Color fundus image · 45 degree fundus photograph · NIDEK AFC-230 · nonmydriatic · 848x848px — 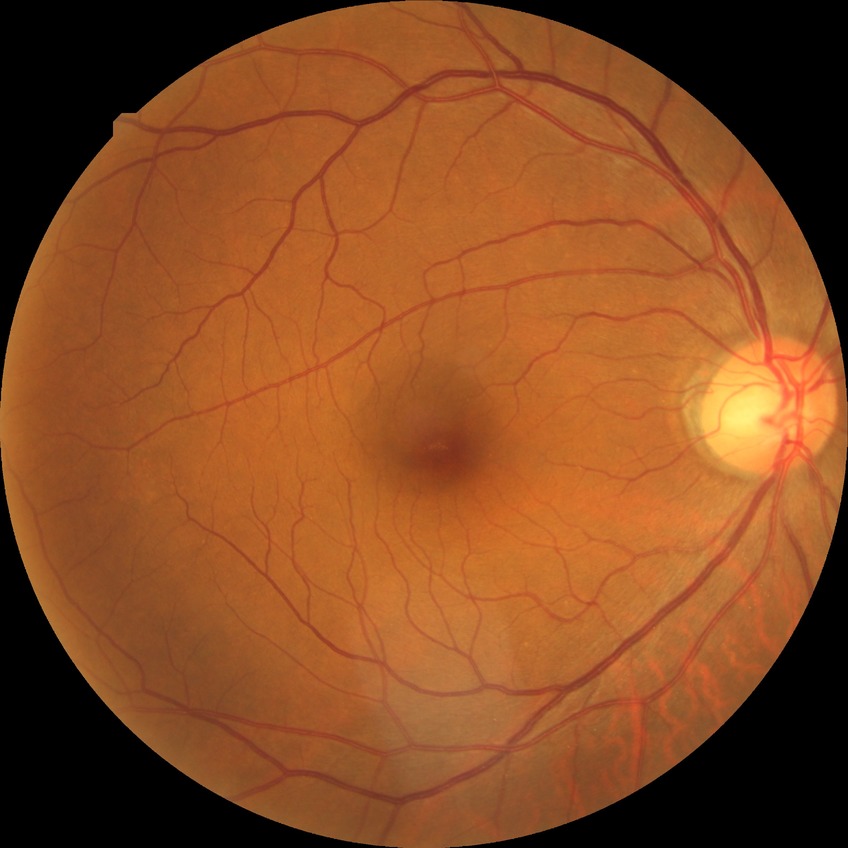

Diabetic retinopathy (DR) is NDR (no diabetic retinopathy).